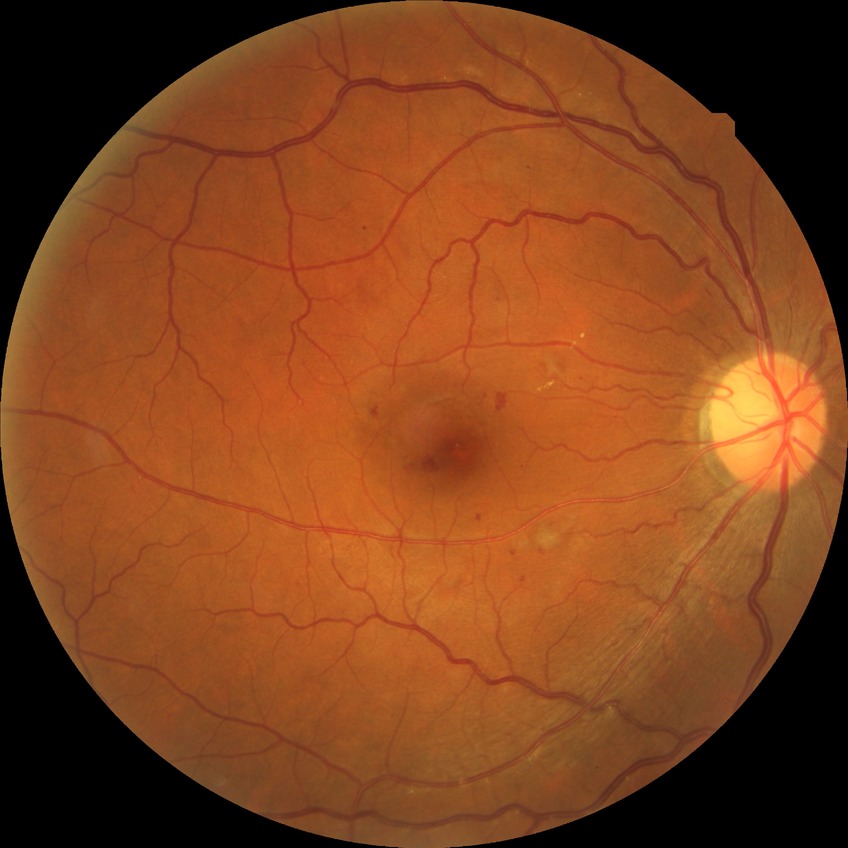   davis_grade: simple diabetic retinopathy